2228 x 1652 pixels. Color fundus photograph:
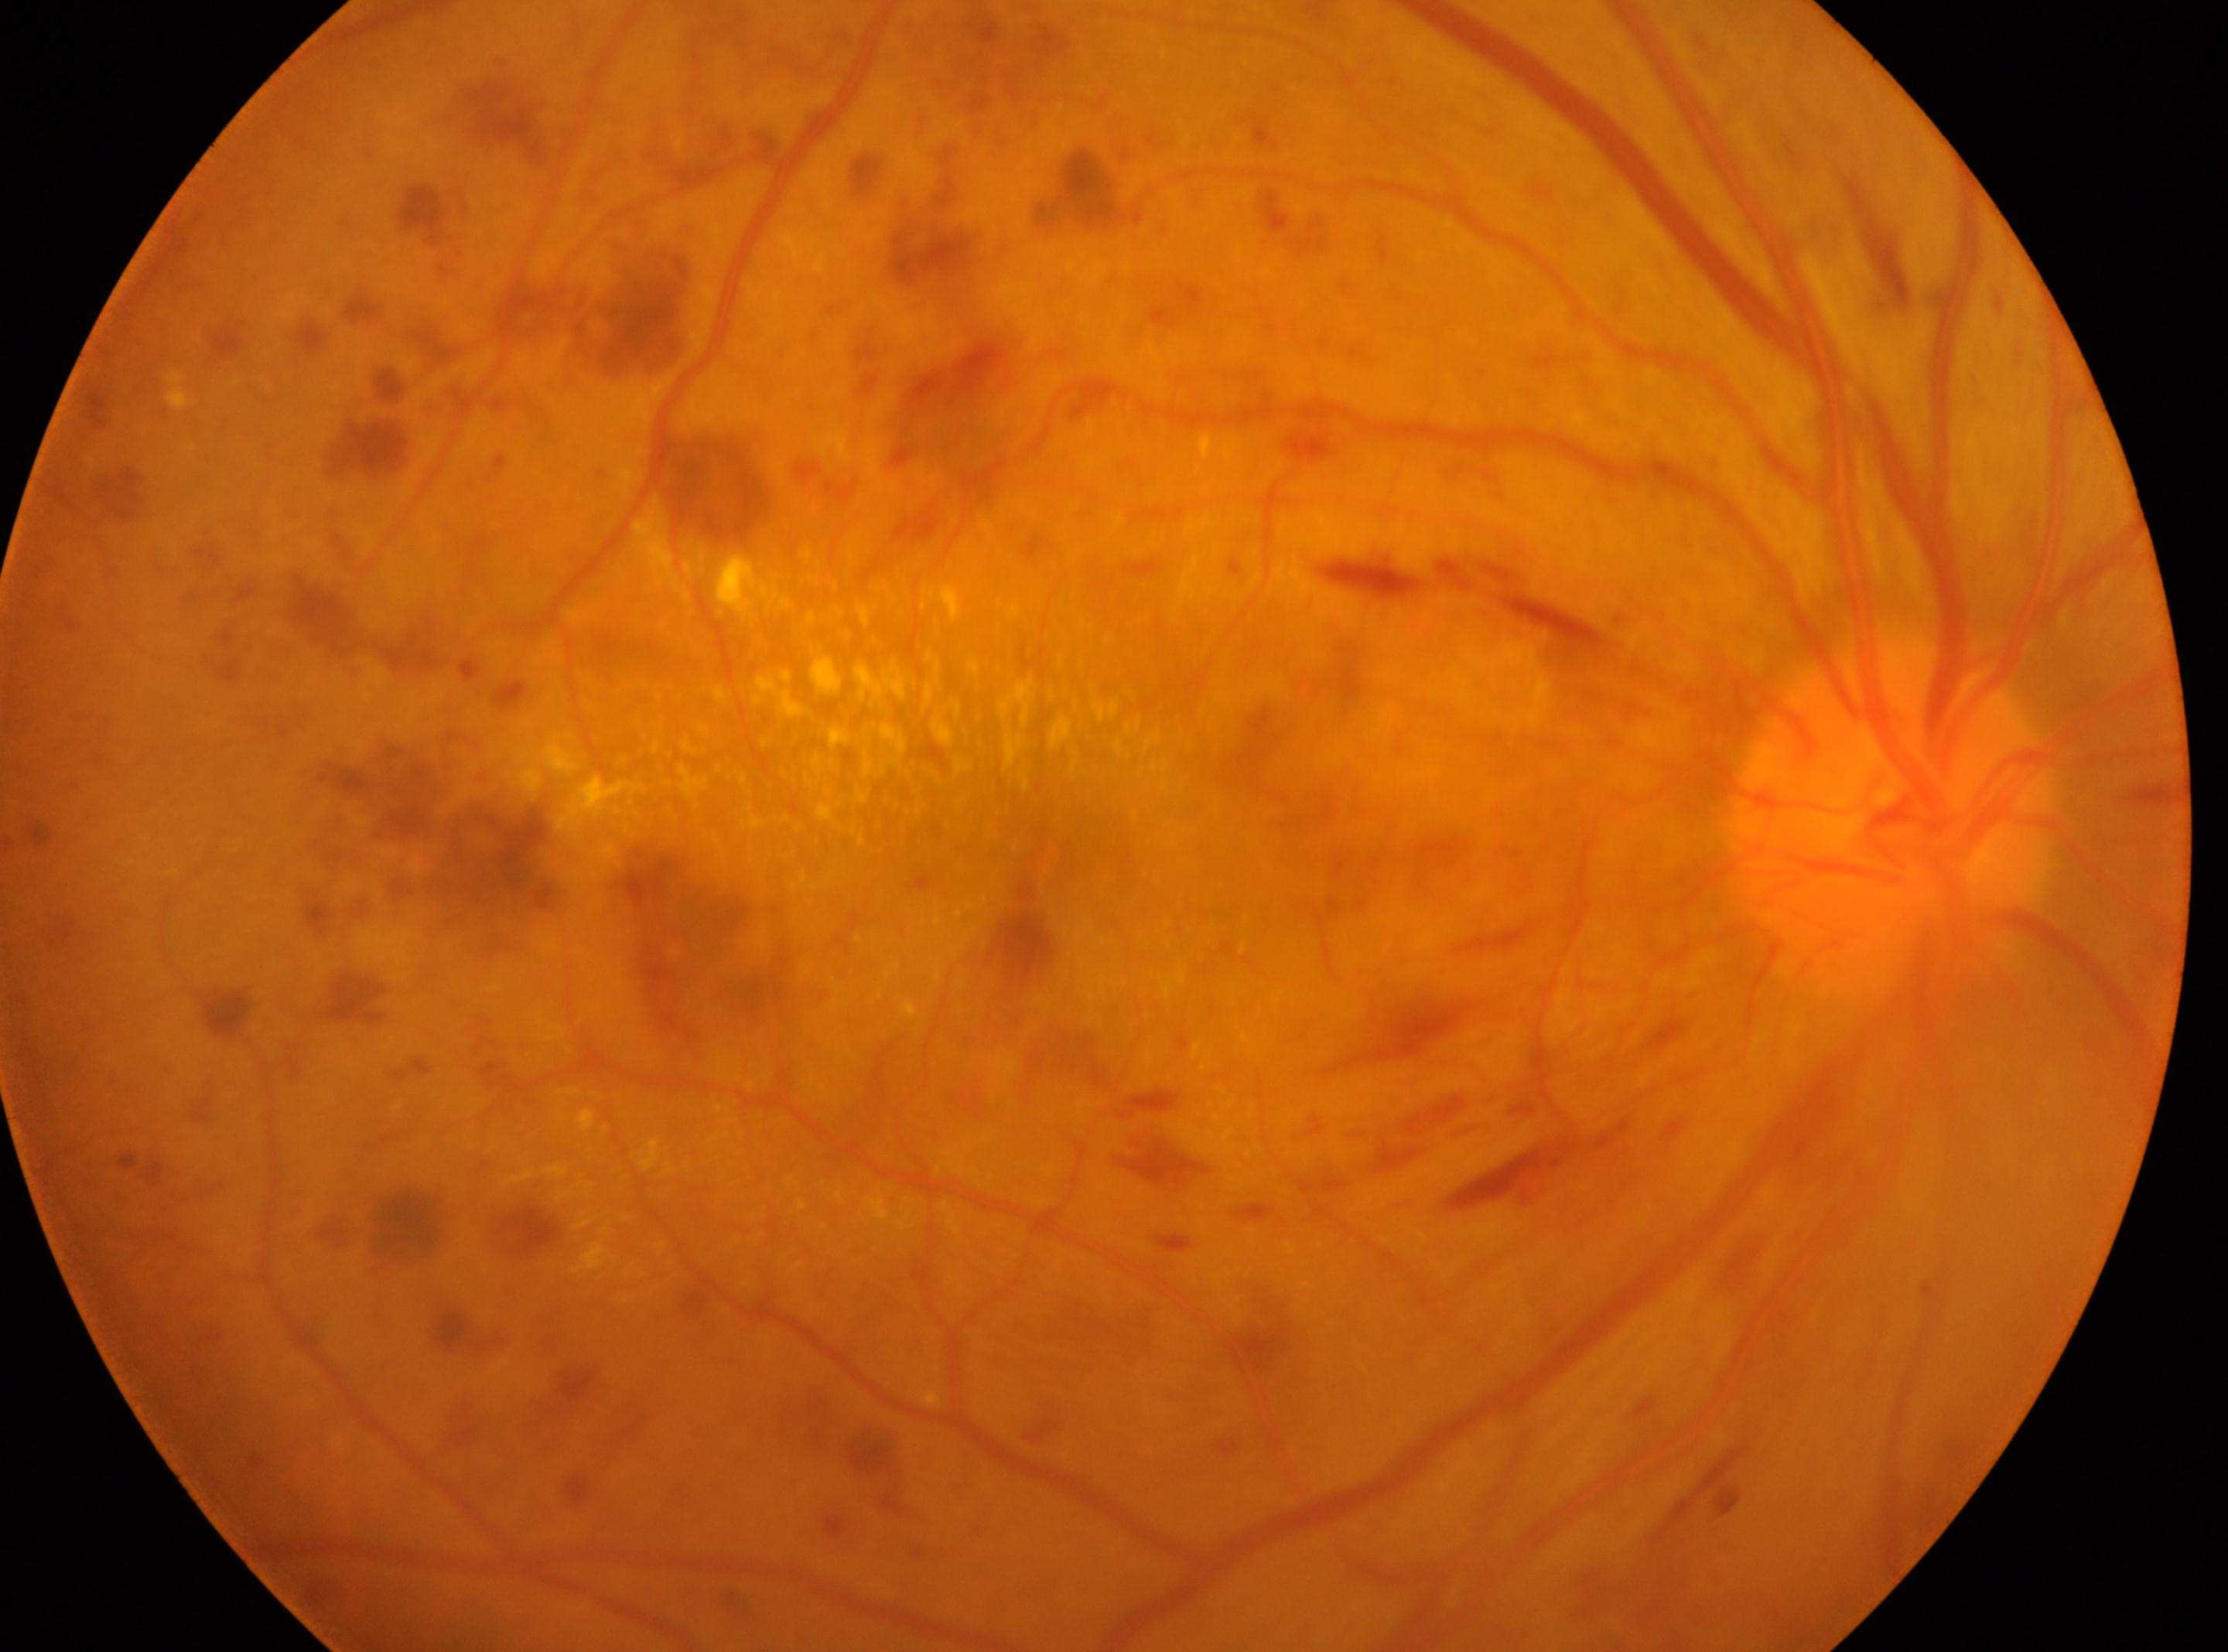 This is the OD.
Macular center located at (1051,848).
DR: grade 4.
The optic disc center is at (1886,812).